90-year-old patient · axial length (AL) 21.86 mm · IOP by Perkins applanation tonometry: 16 mmHg · central corneal thickness 520 µm · refractive error: -0.25 -1.25 x 75 · optic disc-centered · perimetry mean defect: -3.31 dB · gender: F
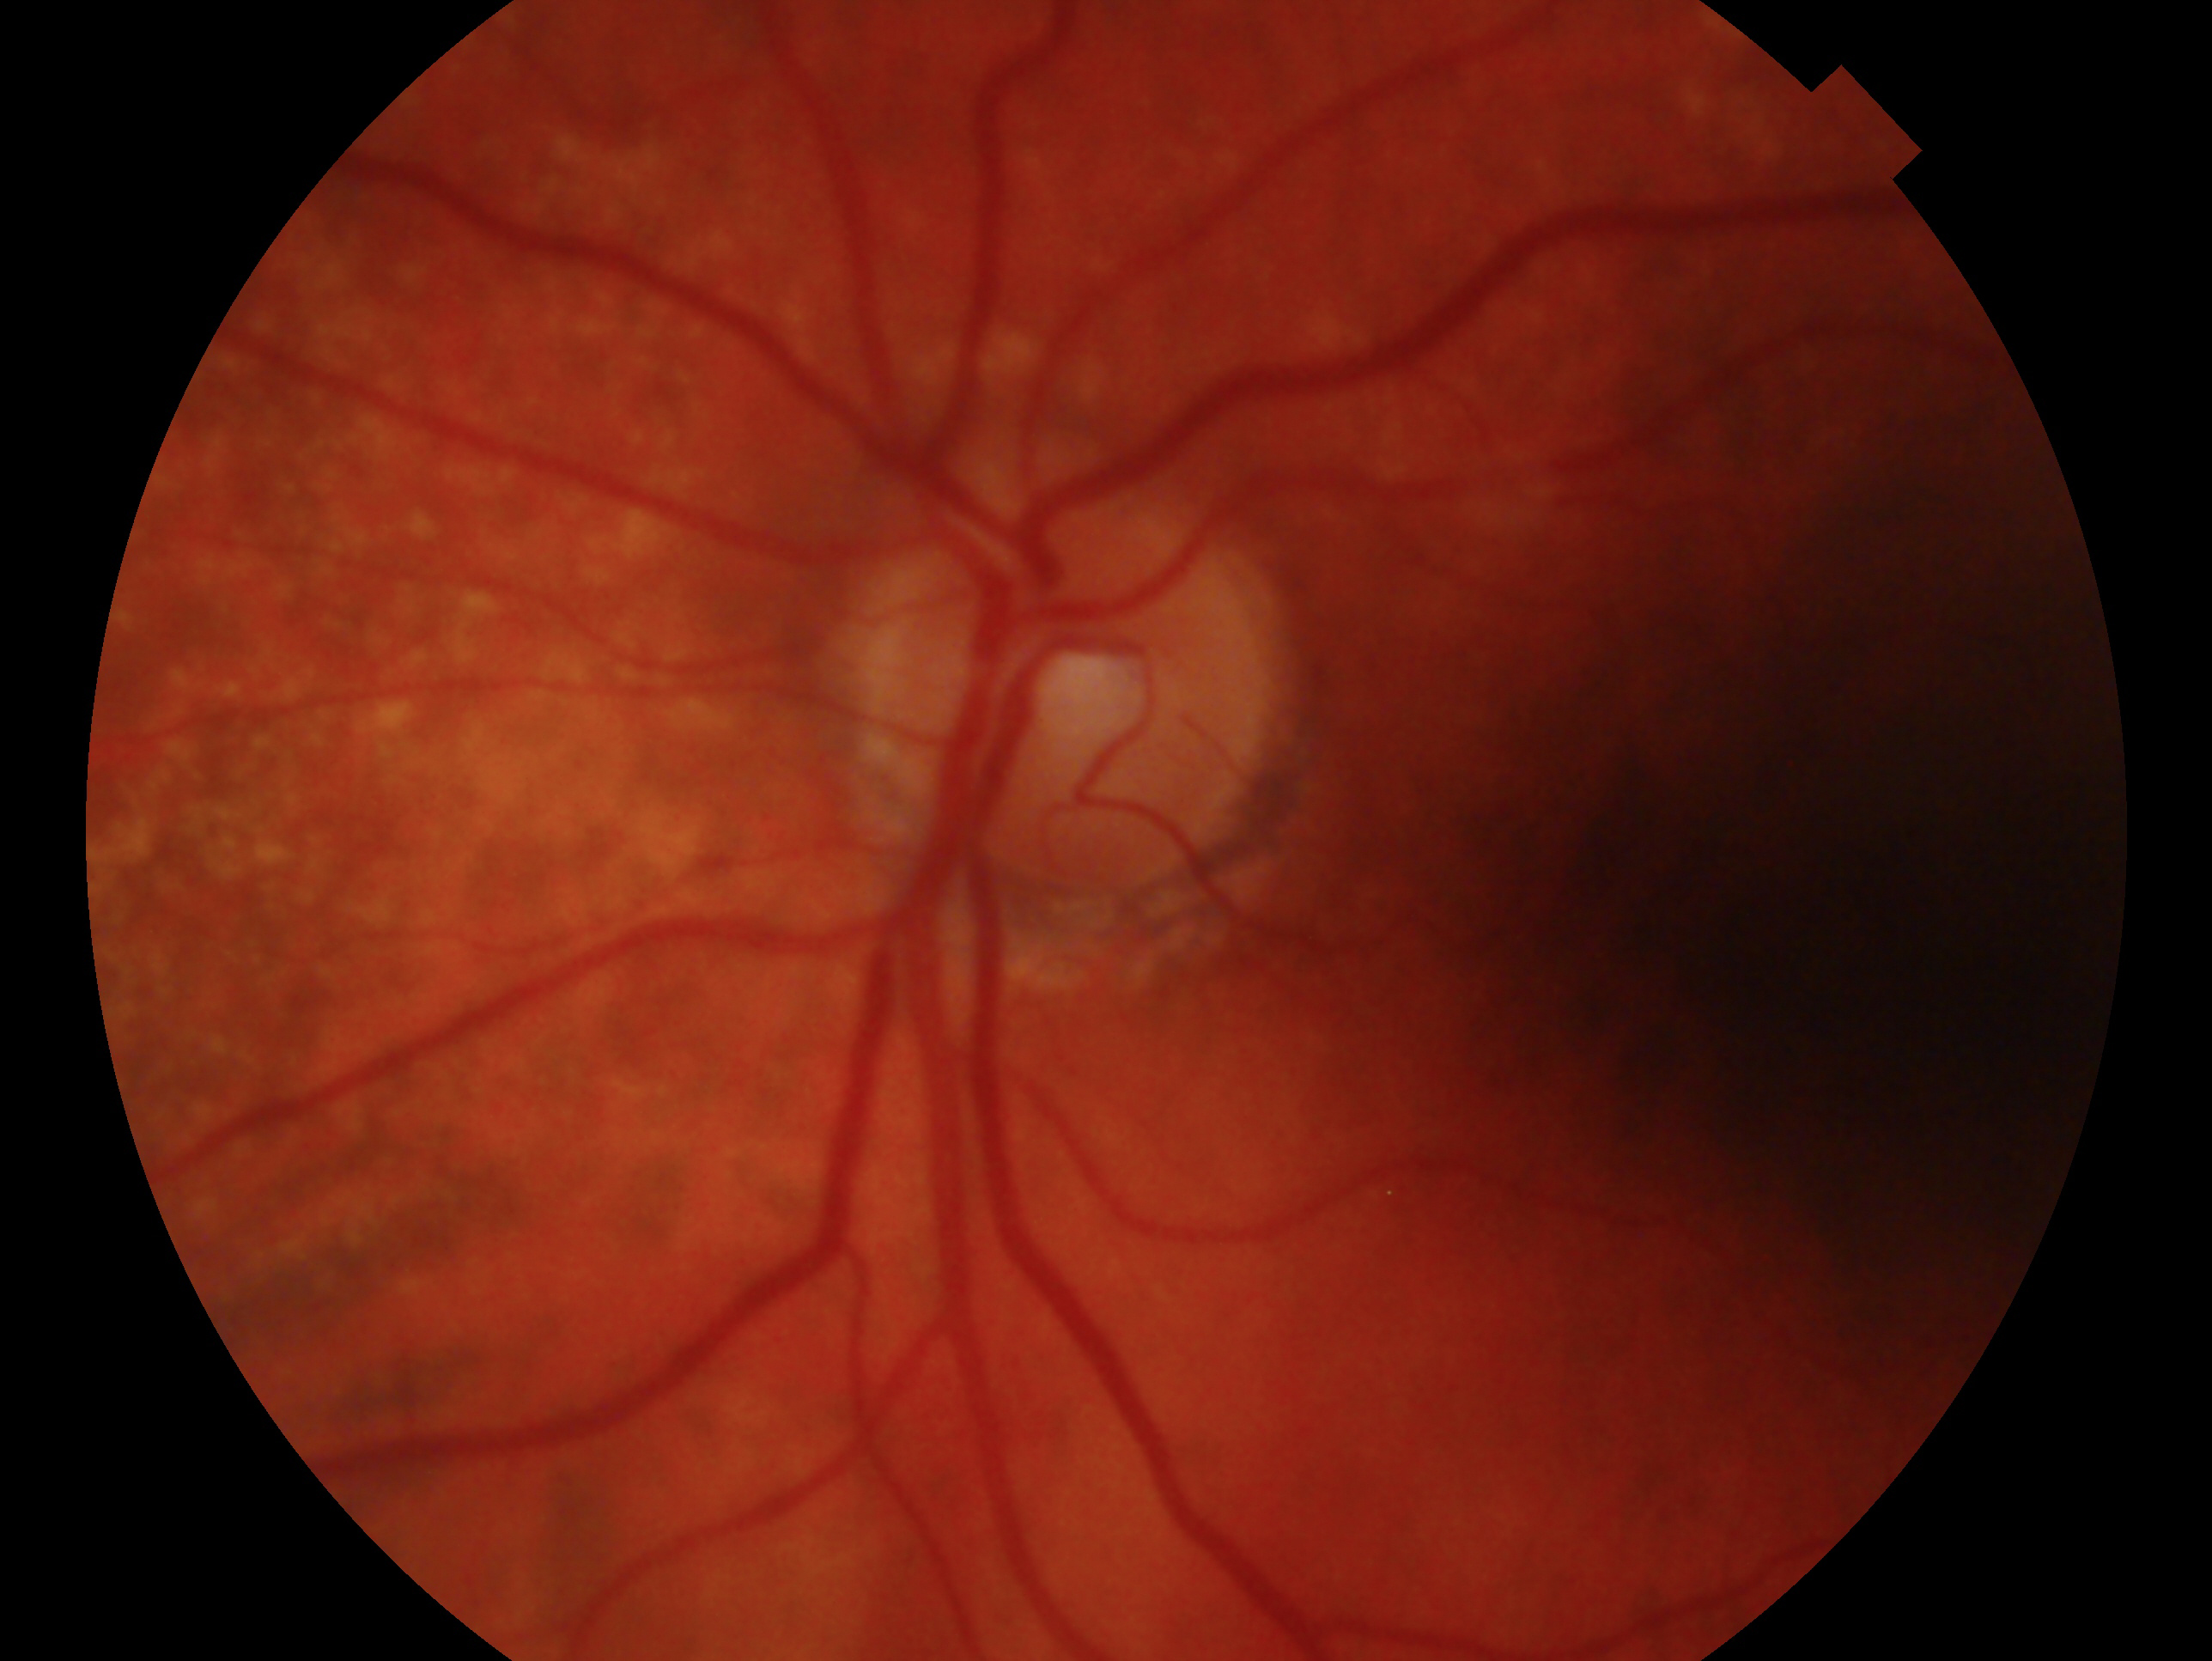

eye: OS | diagnosis: glaucomatous optic neuropathy.